Phoenix ICON, 100° FOV; wide-field fundus photograph of an infant — 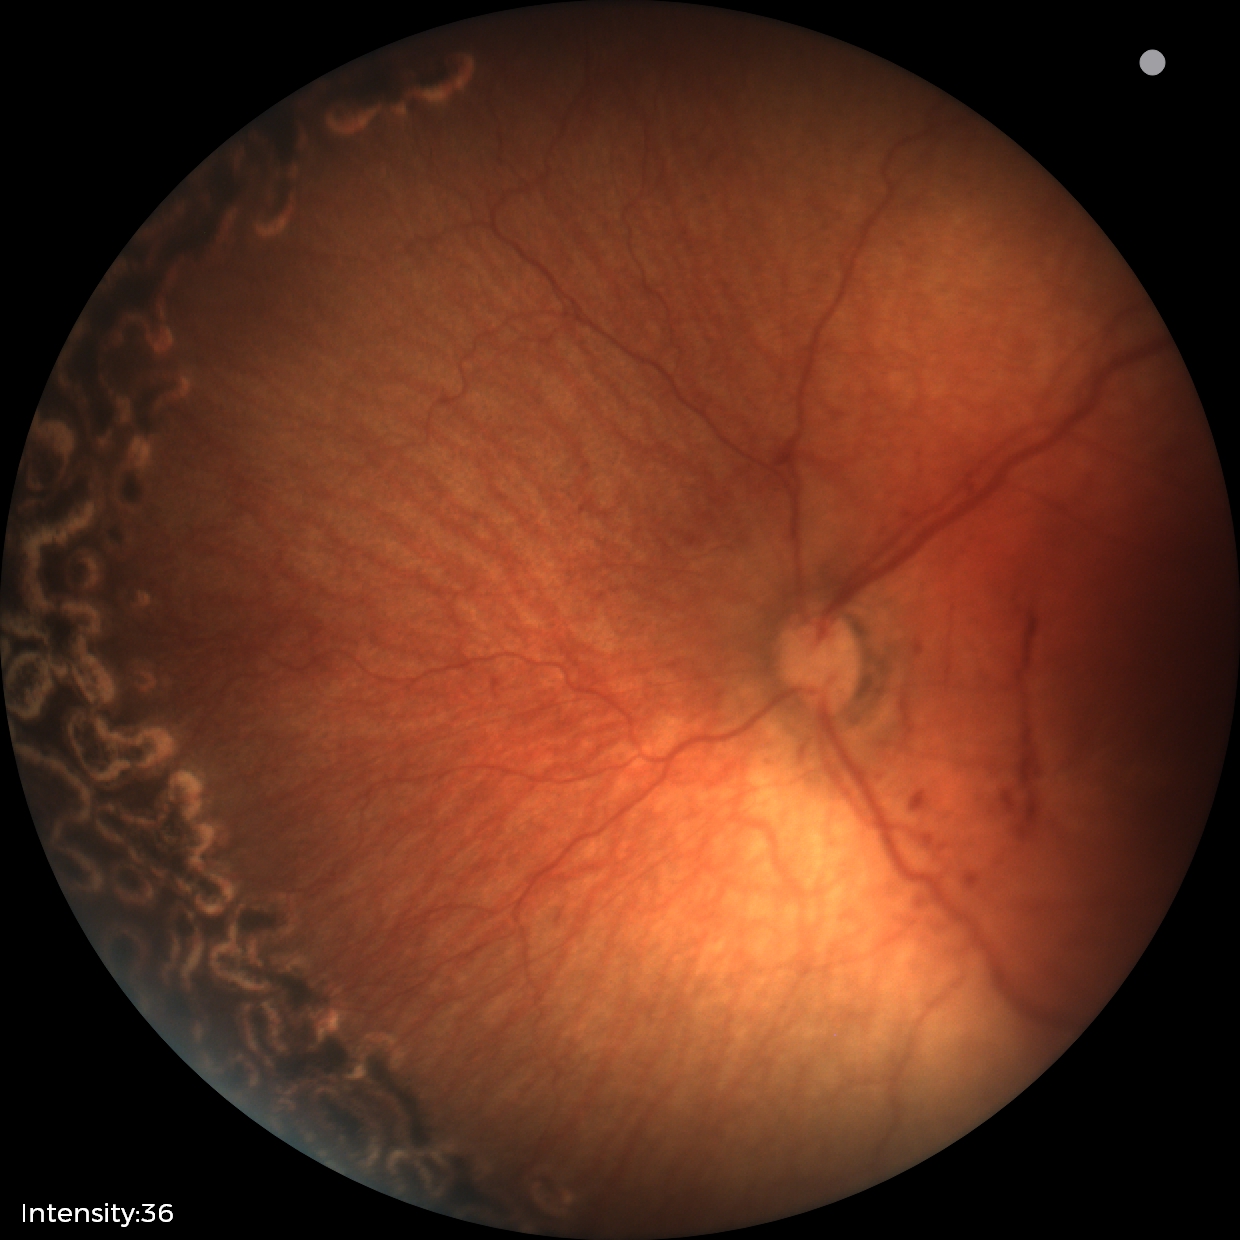 From an examination with diagnosis of status post ROP.